45° FOV
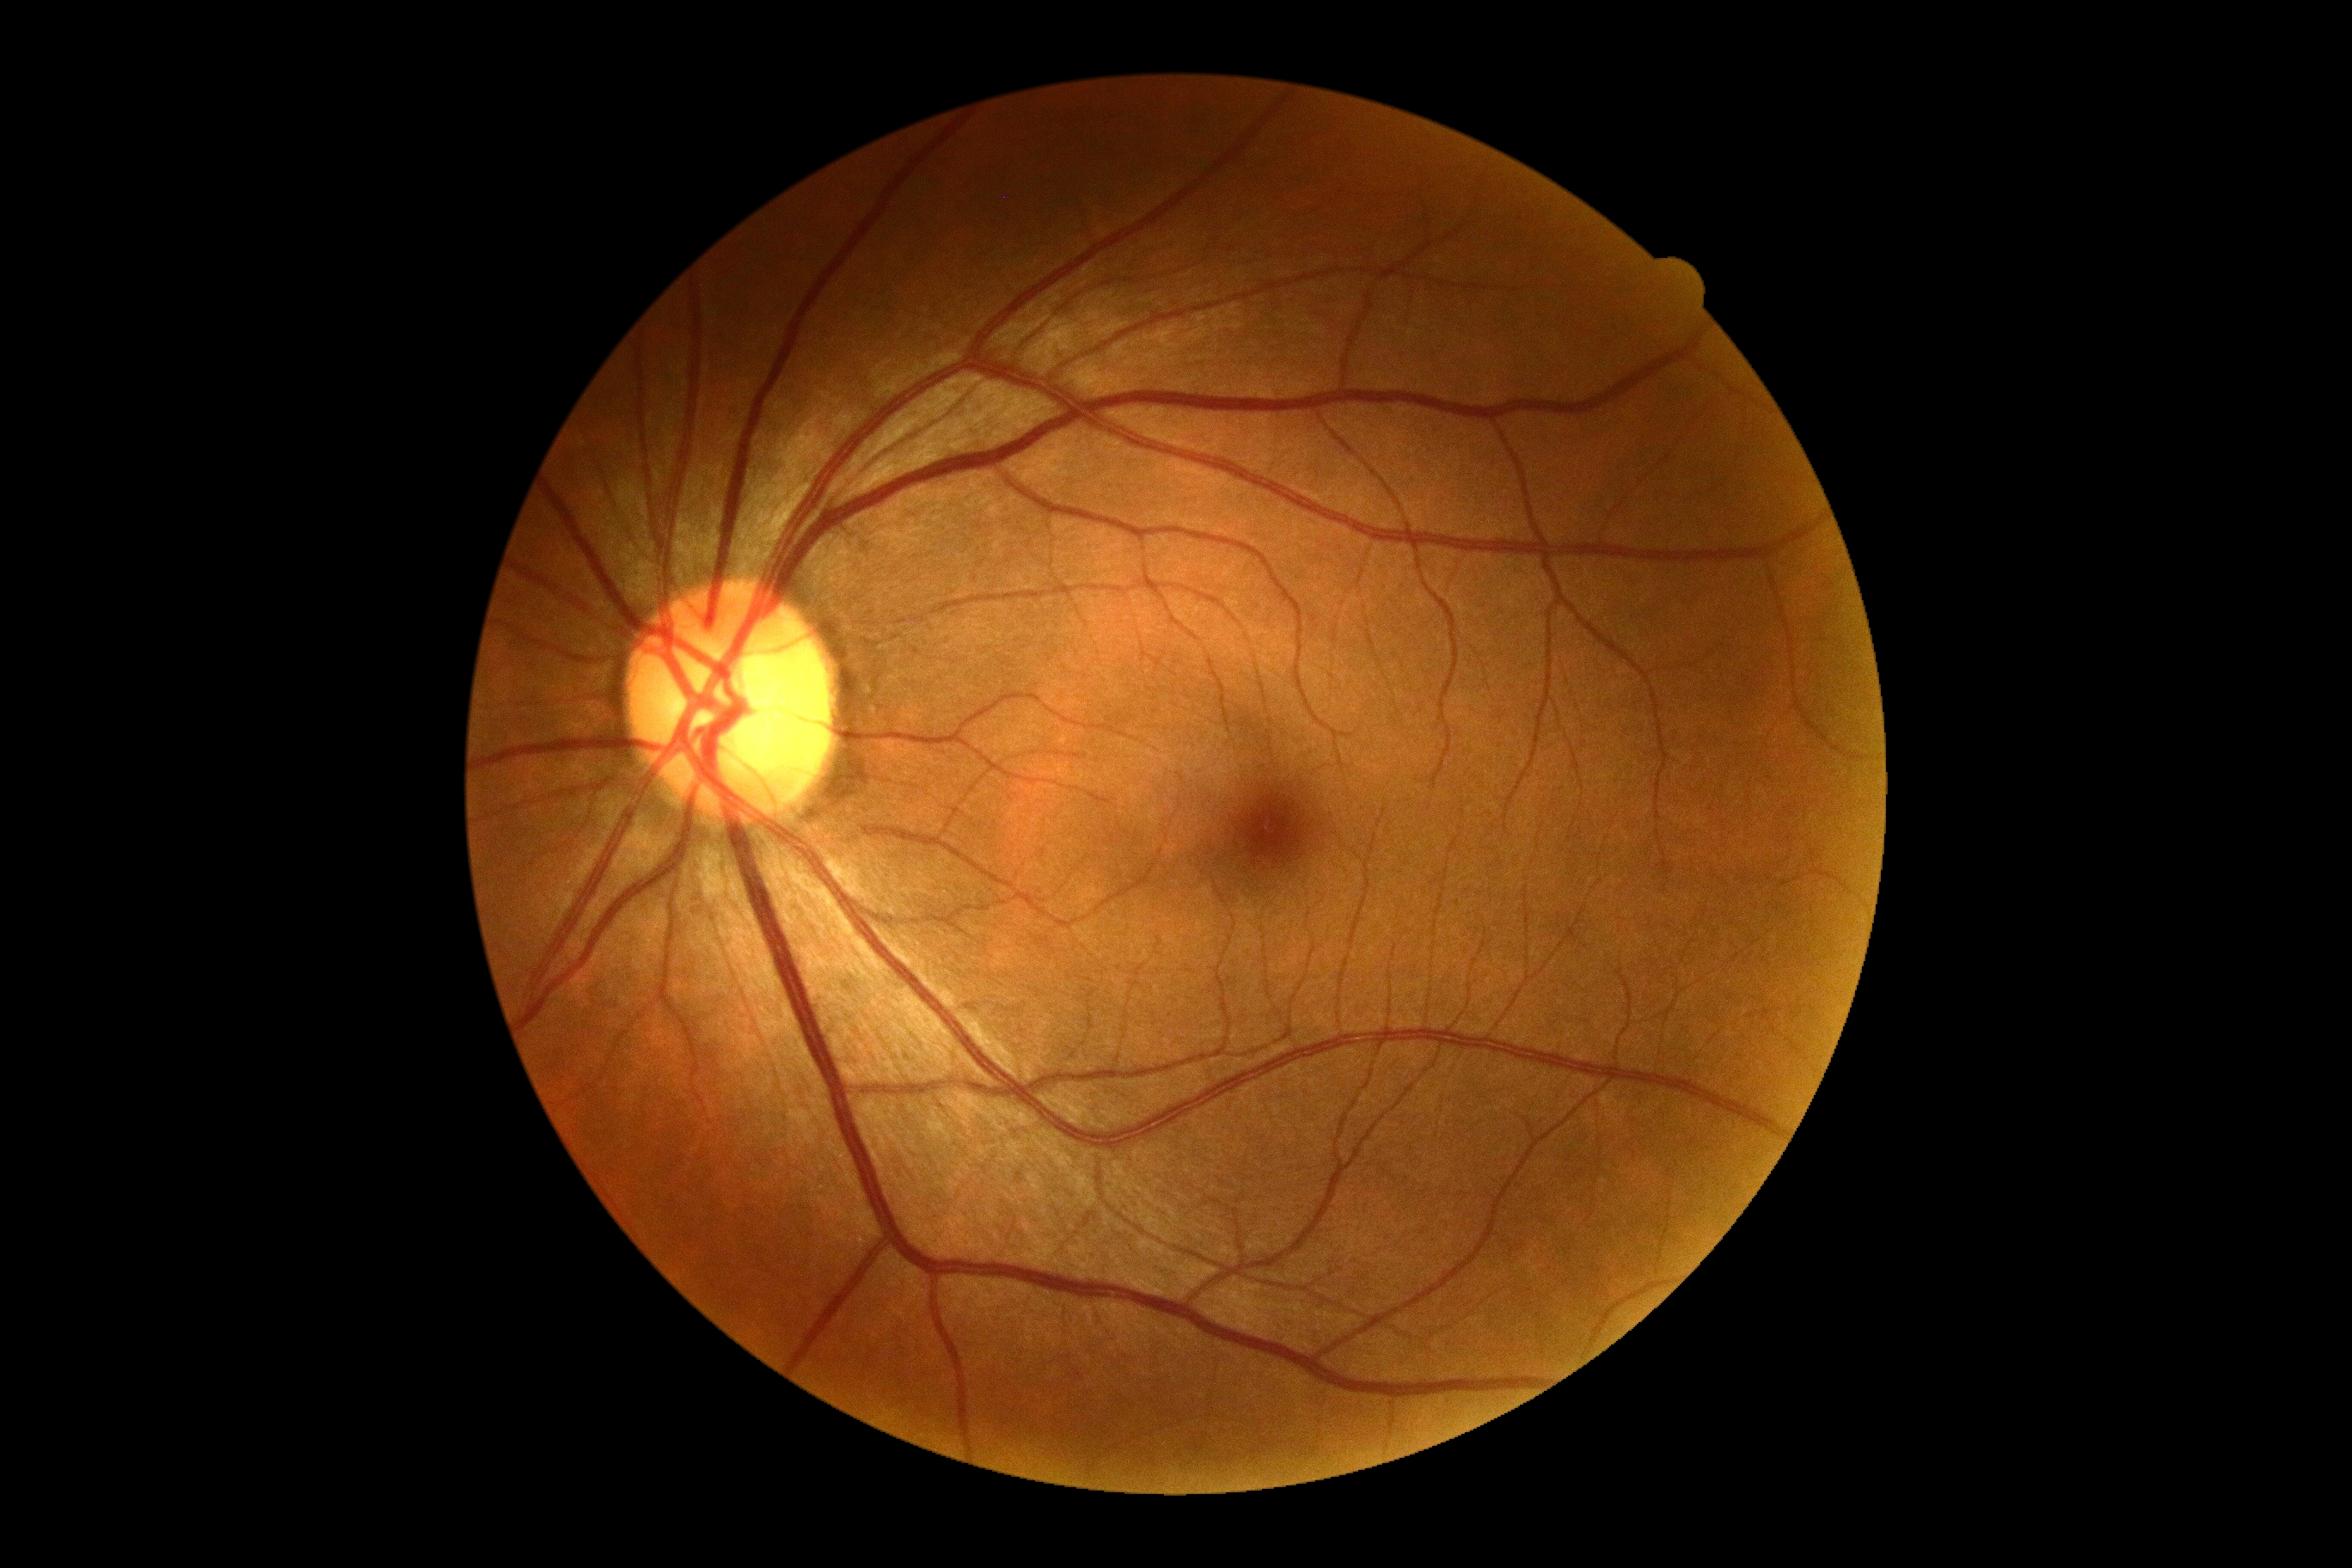
DR impression: negative for DR; retinopathy grade: 0/4.